Mydriatic (tropicamide phenylephrine 1.0%):
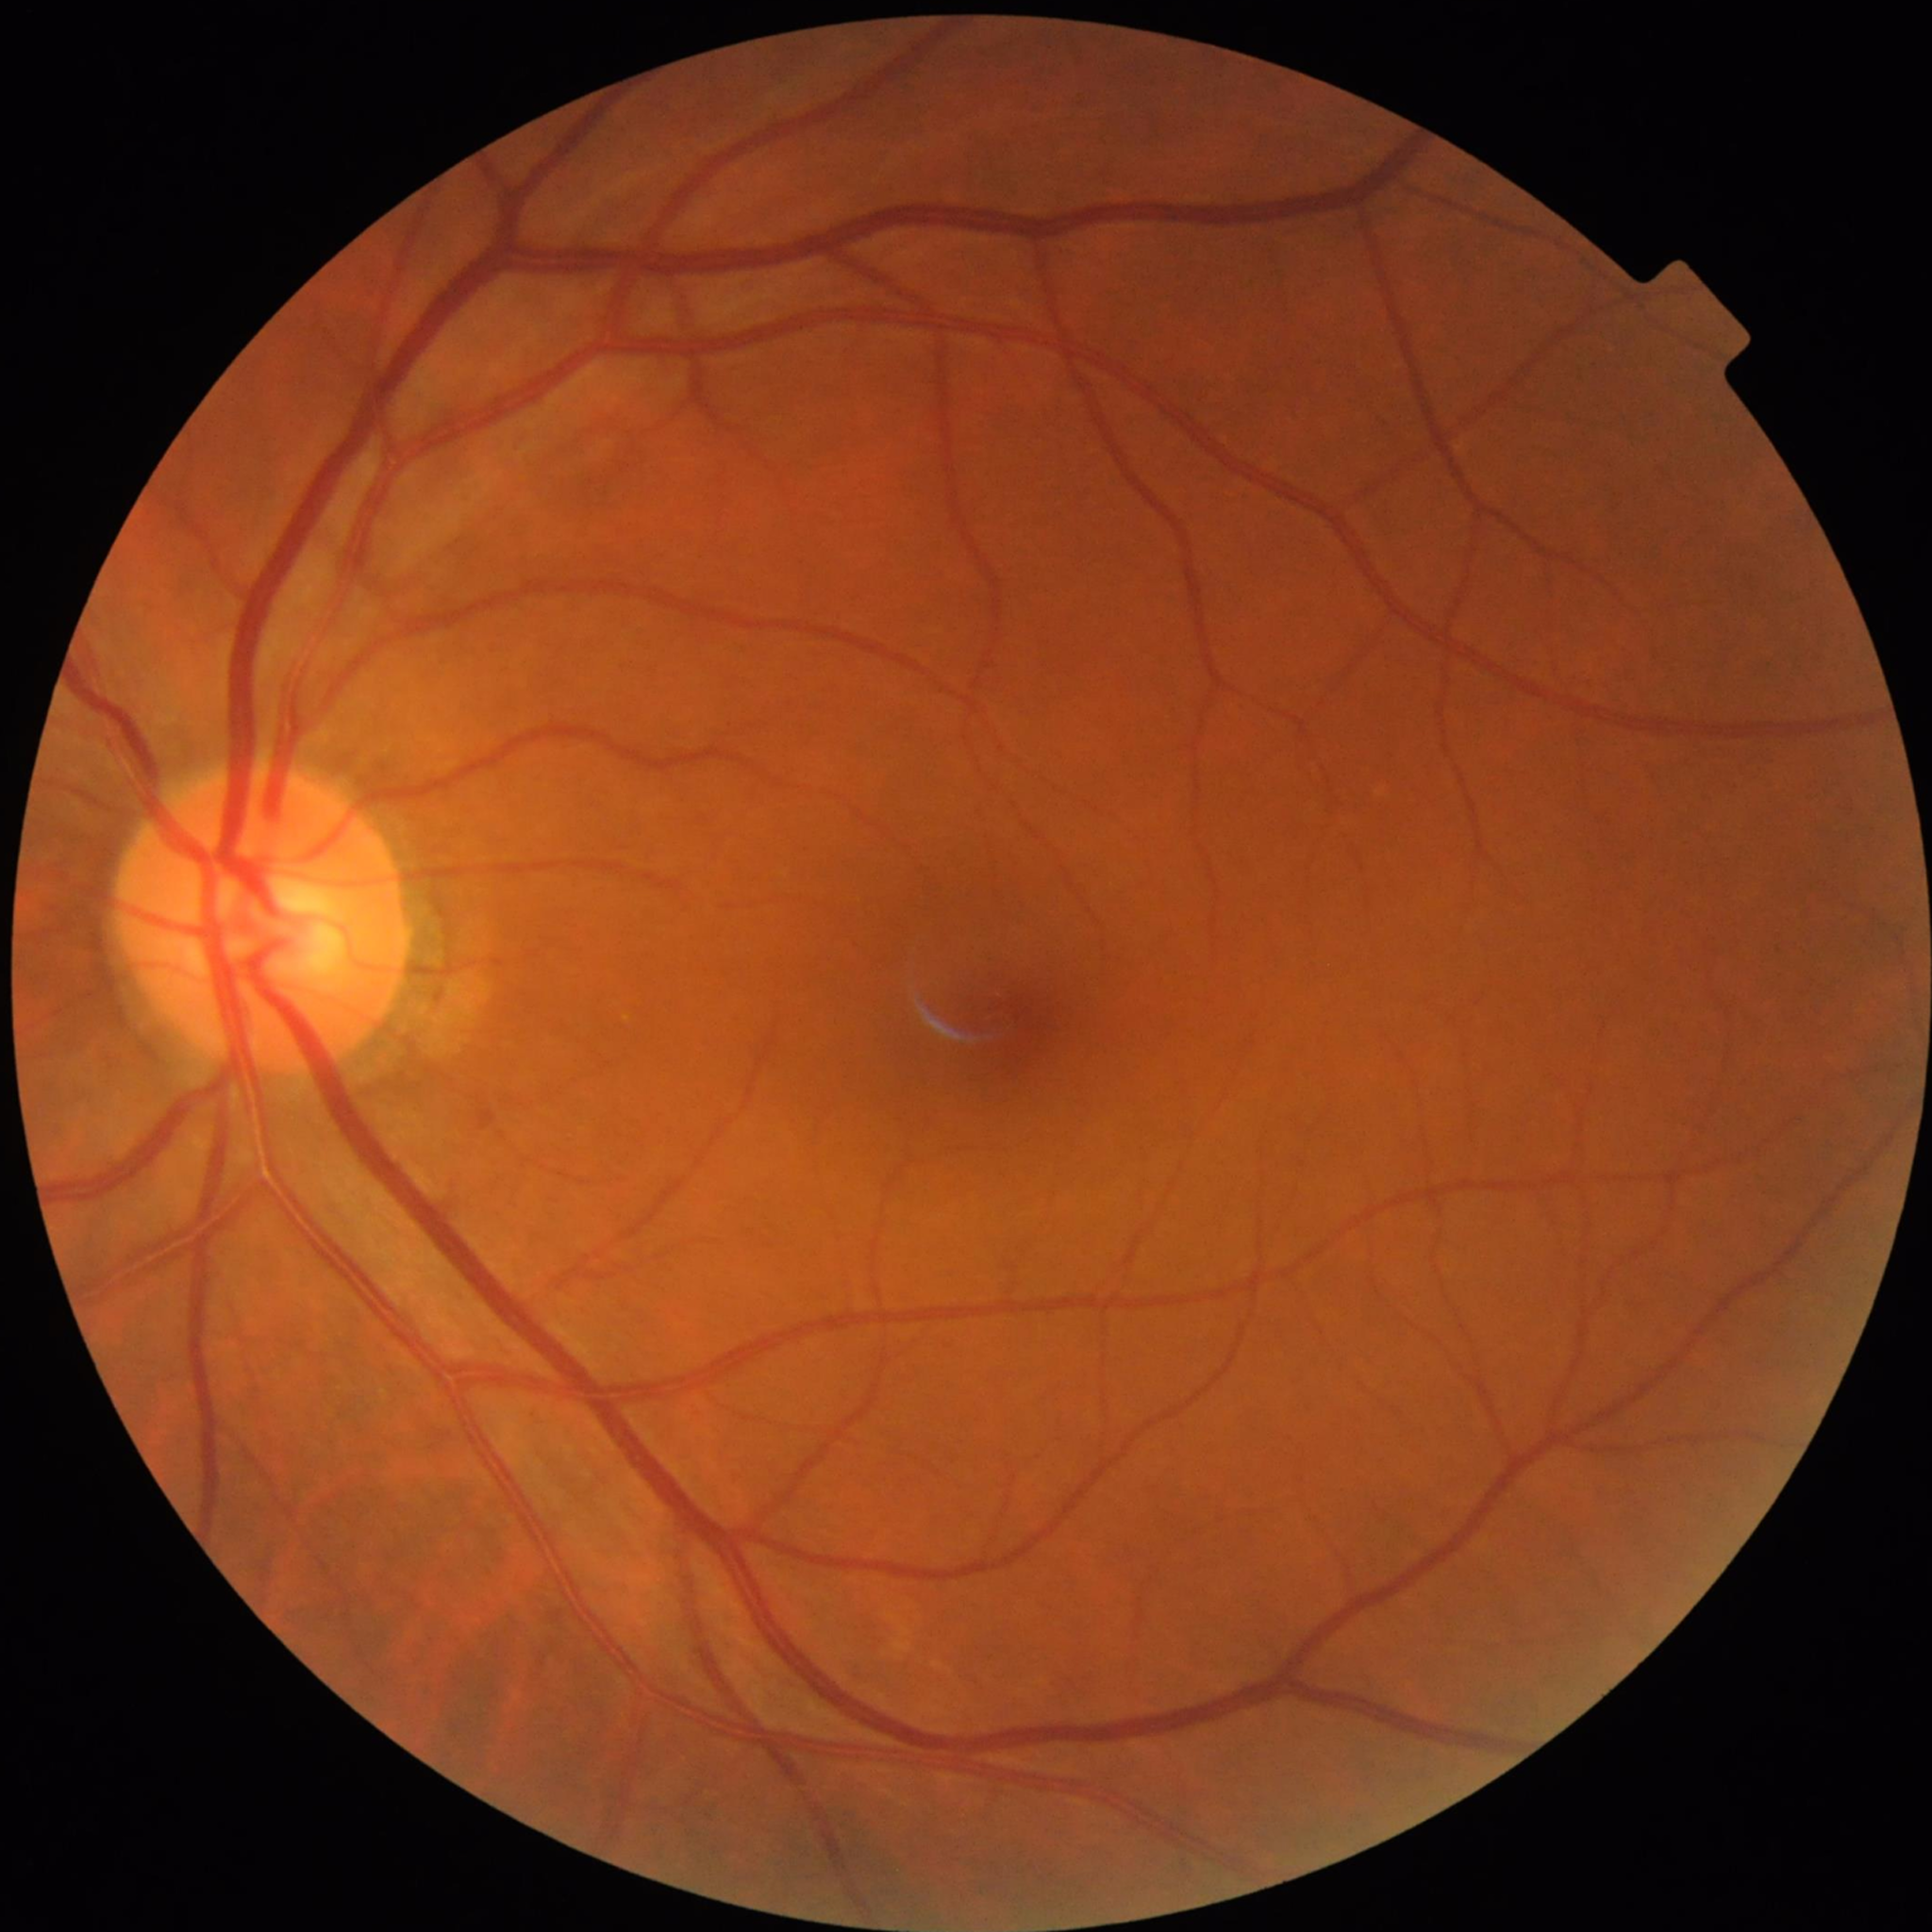

Quality assessment: good. From a control without AMD, diabetic retinopathy, or glaucoma.